Image size 2352x1568 · CFP: 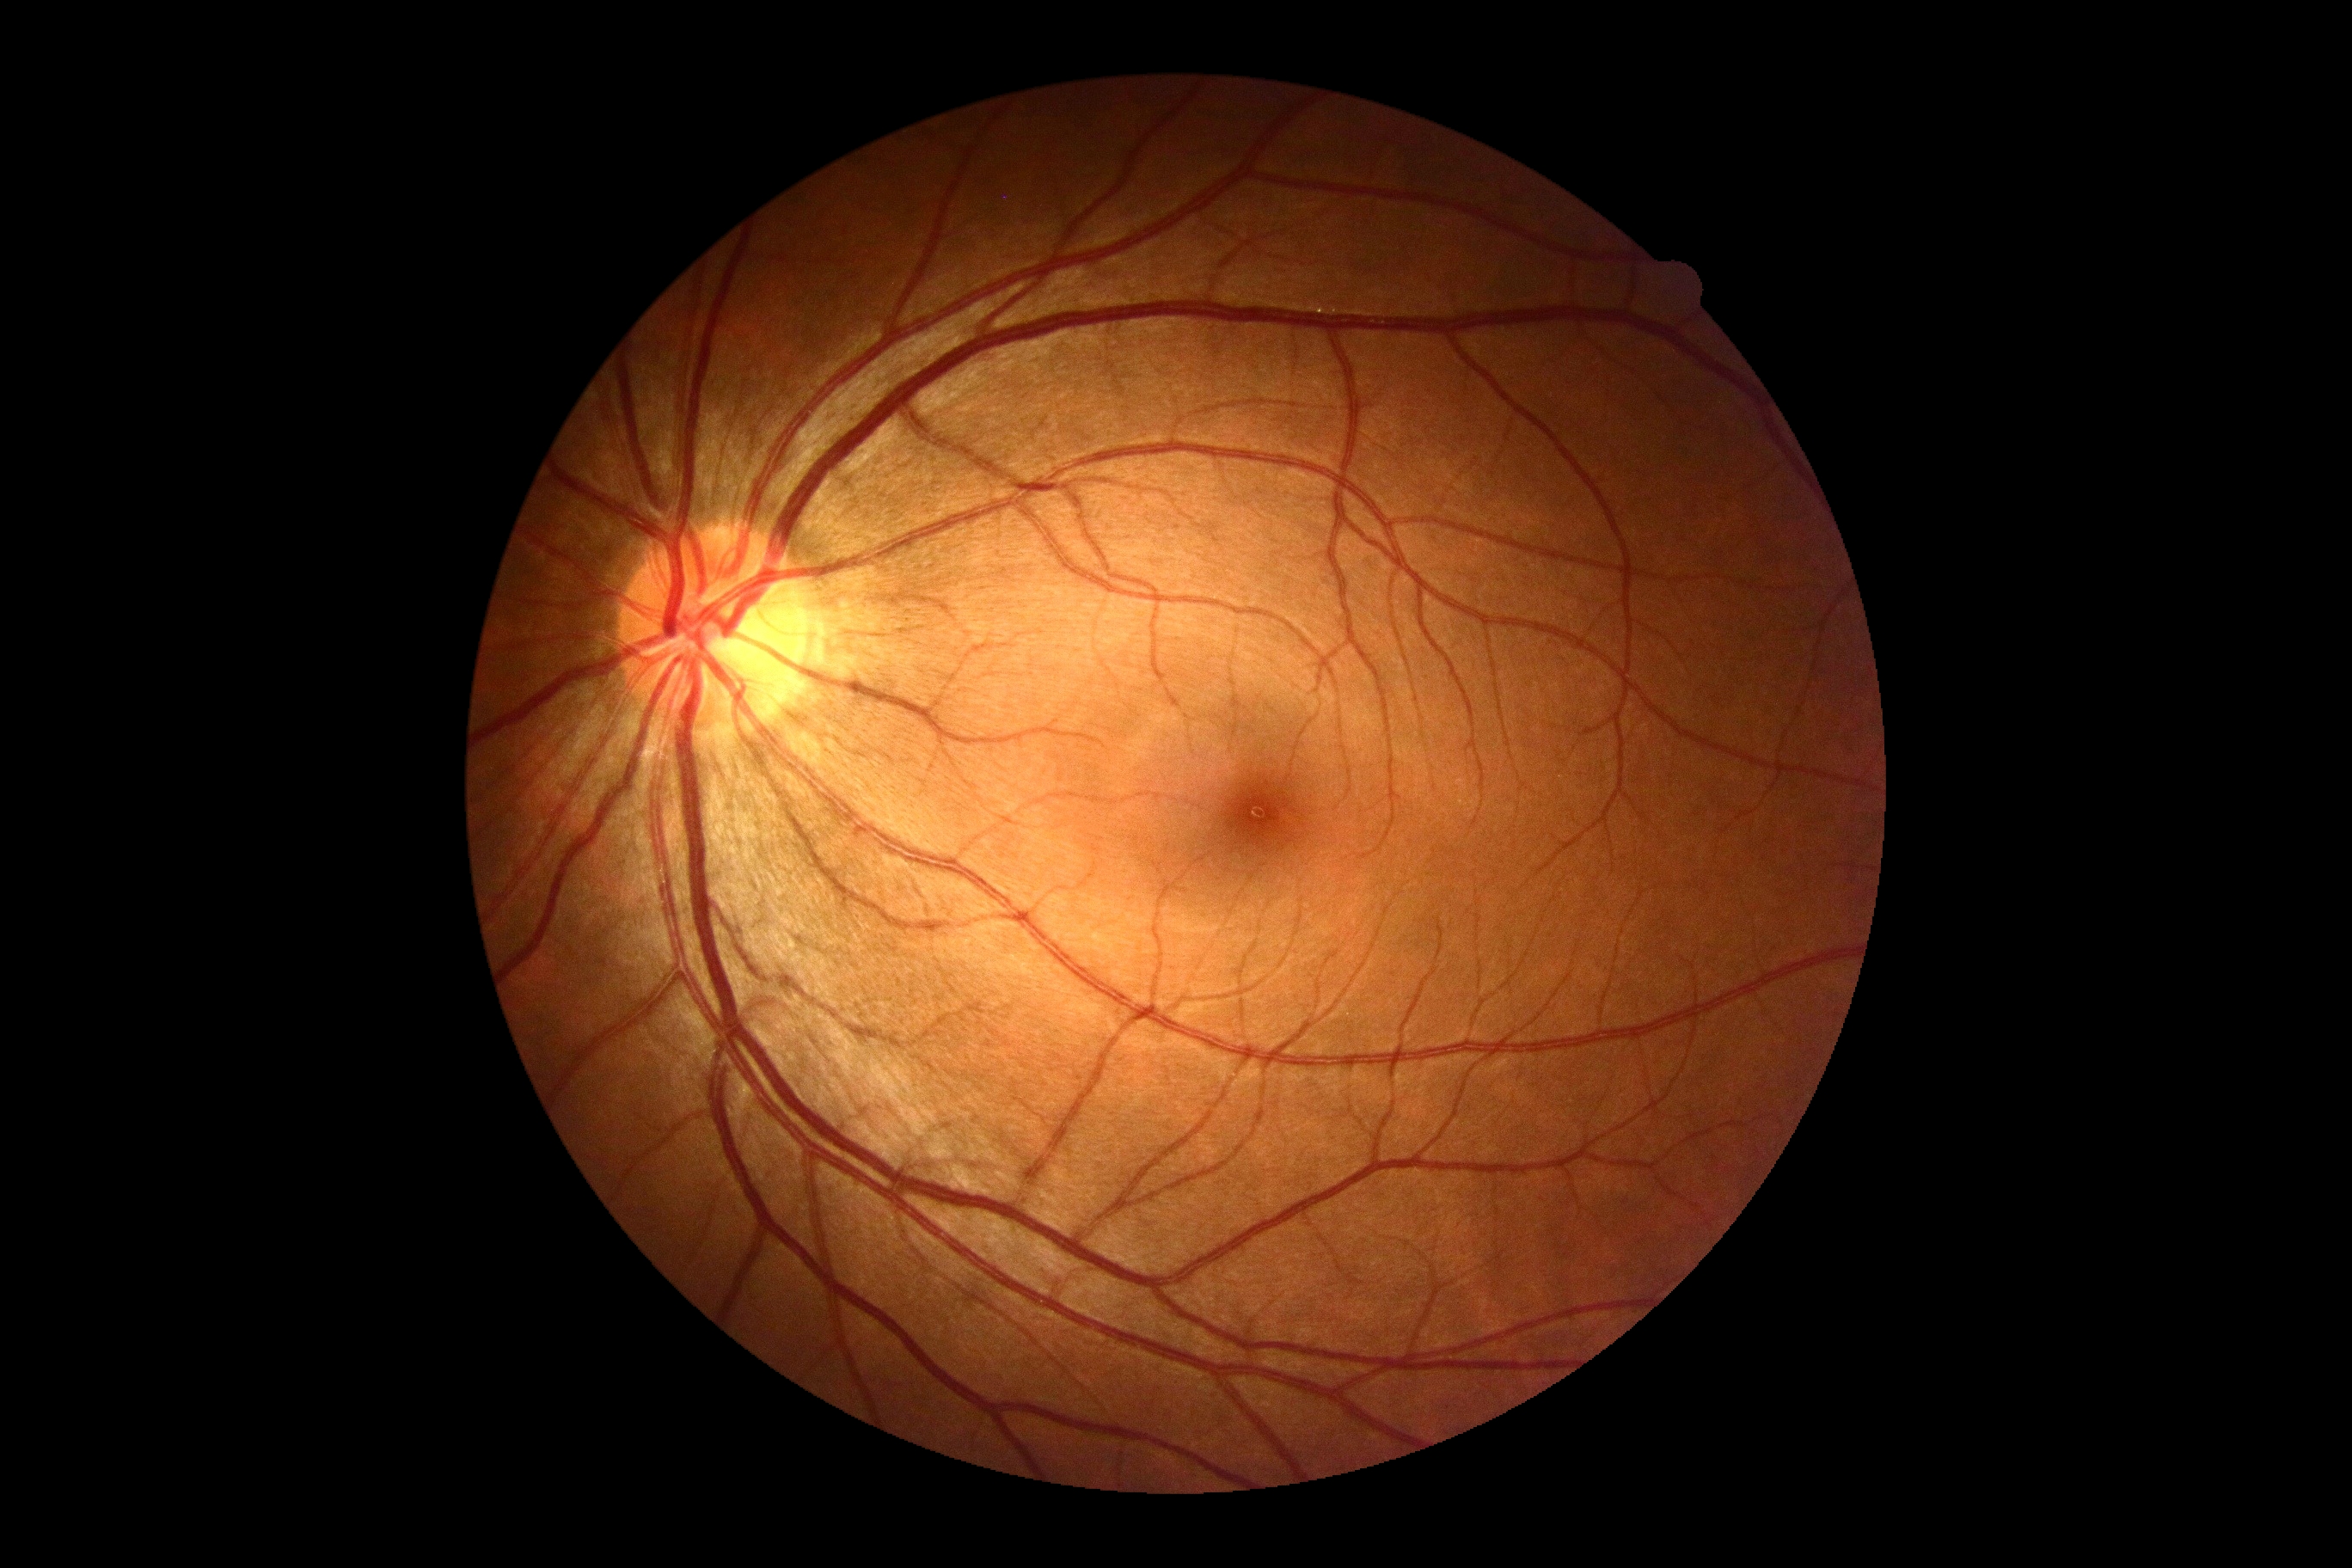 No DR findings. Retinopathy: no apparent retinopathy (grade 0) — no visible signs of diabetic retinopathy.